Modified Davis grading: 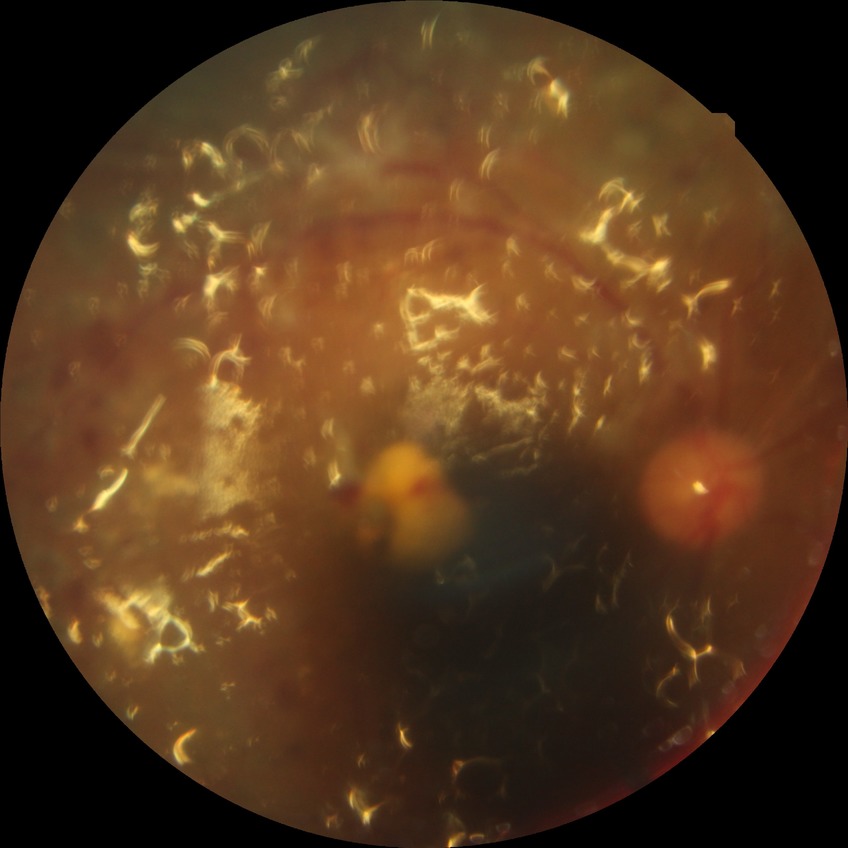

Davis grade: PDR.